1240x1240px. Pediatric wide-field fundus photograph: 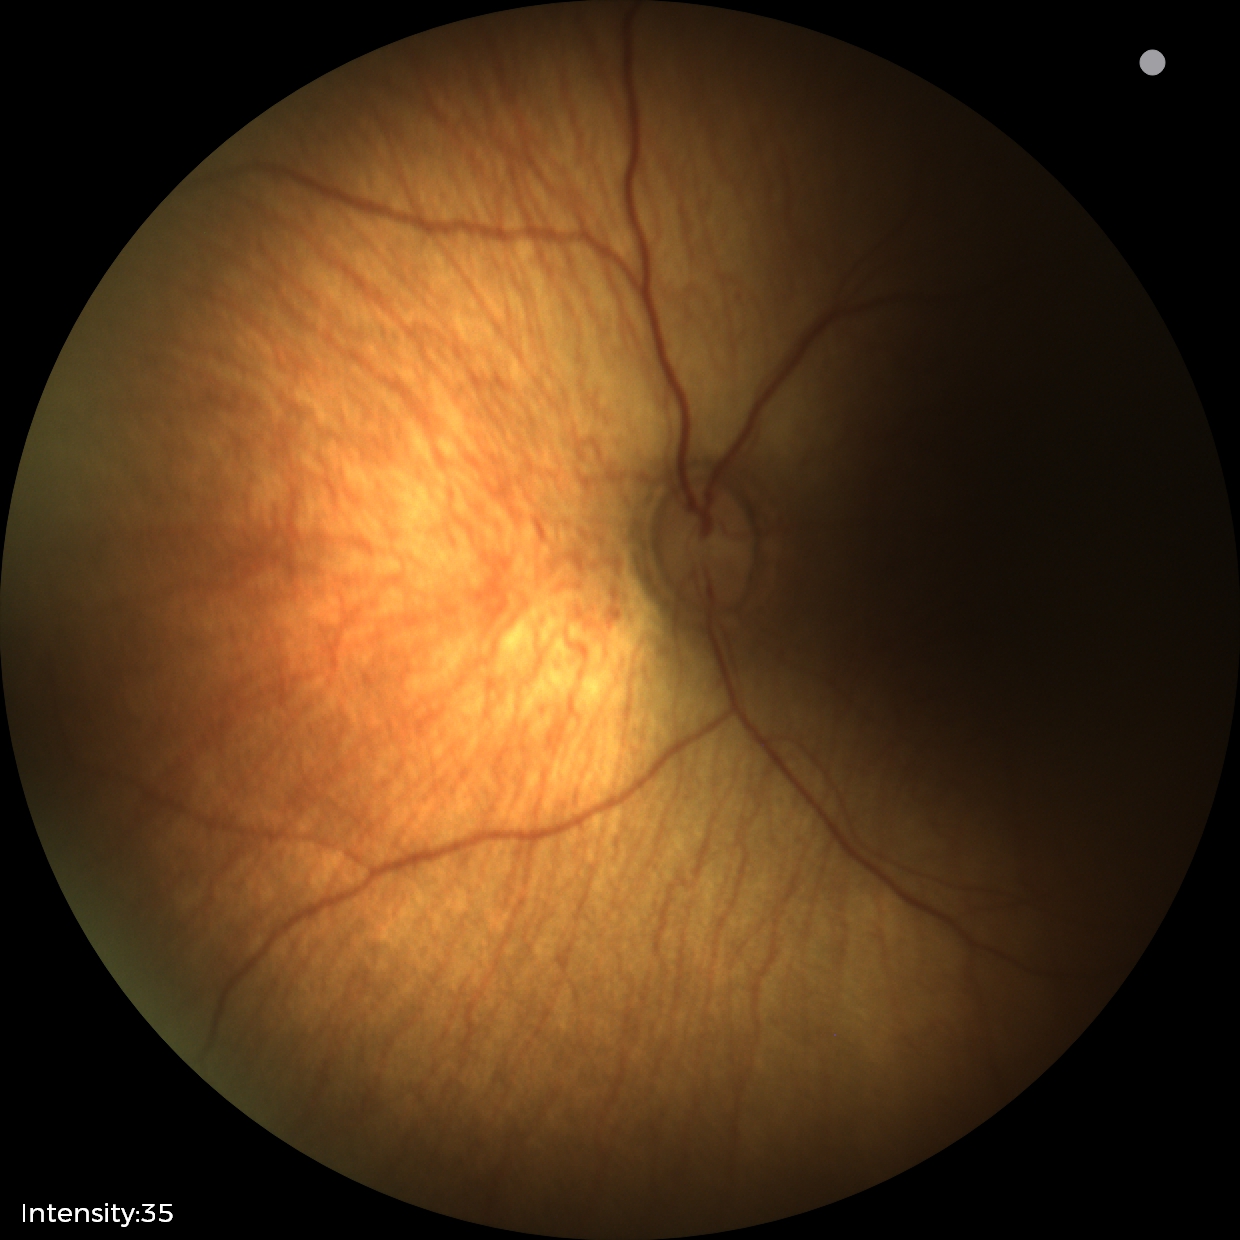

Examination diagnosed as status post ROP. Plus disease absent.